Retinal fundus photograph.
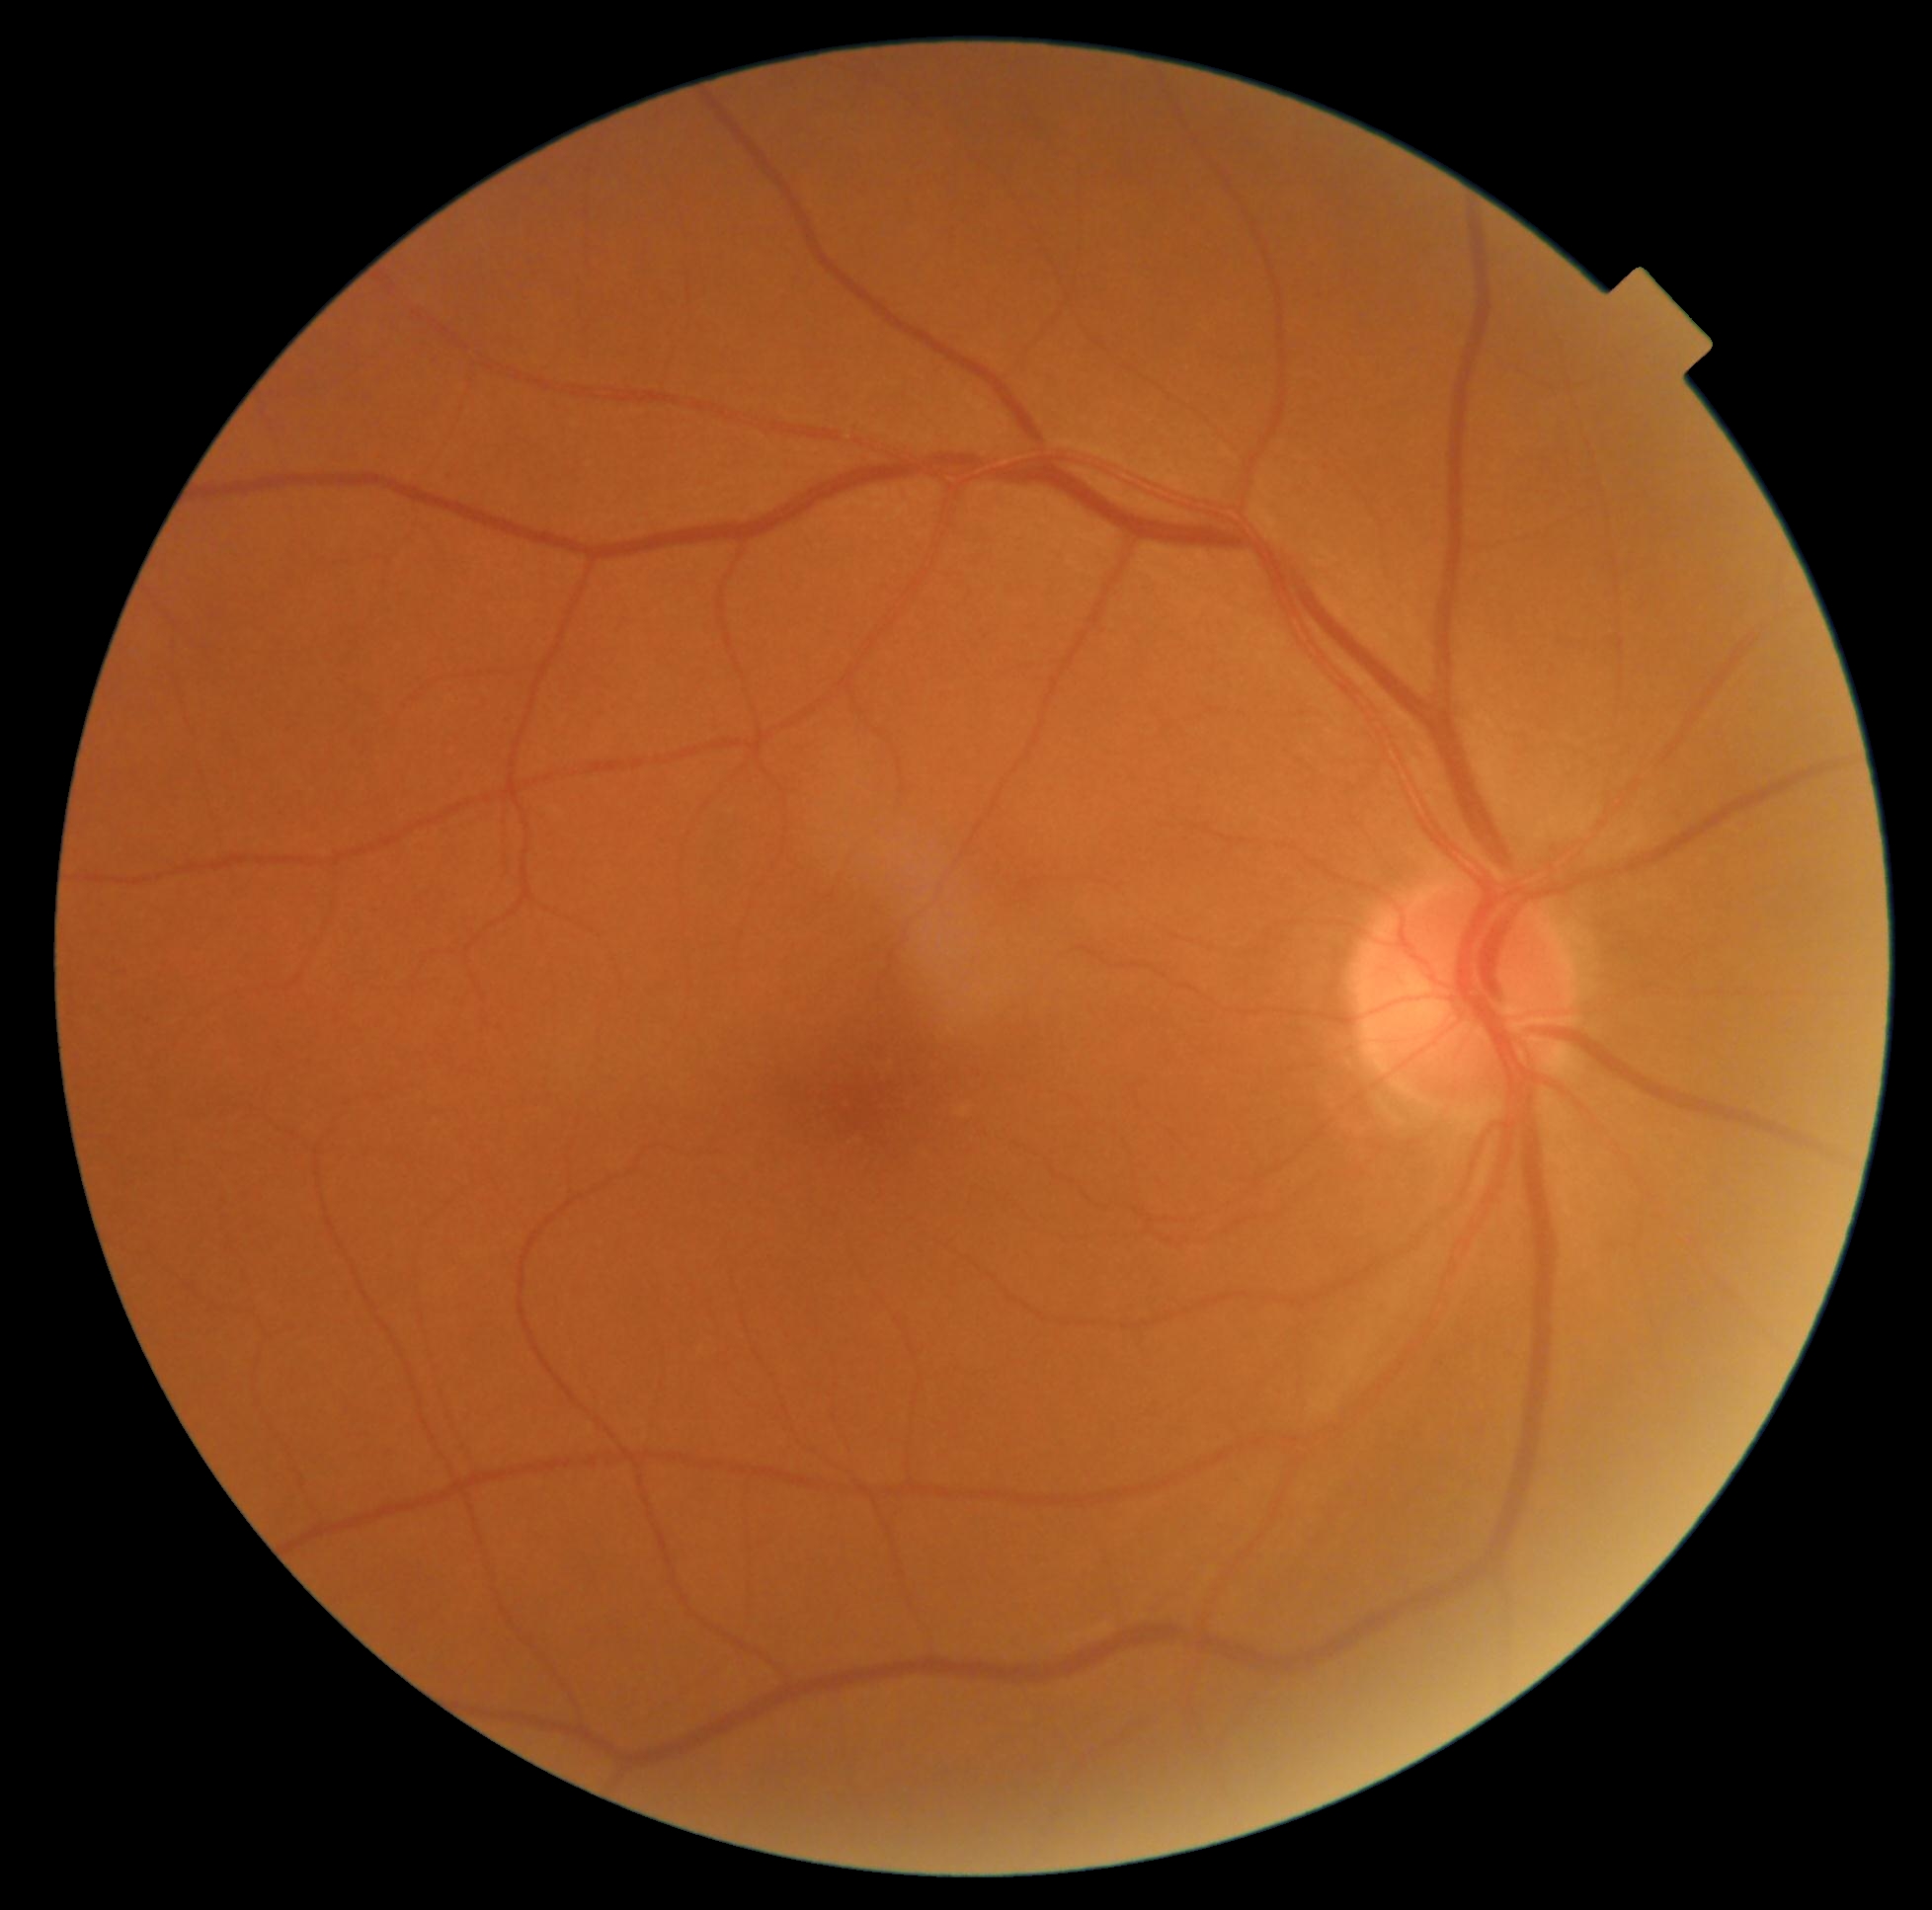
Retinopathy is grade 0.